Retinal fundus photograph — 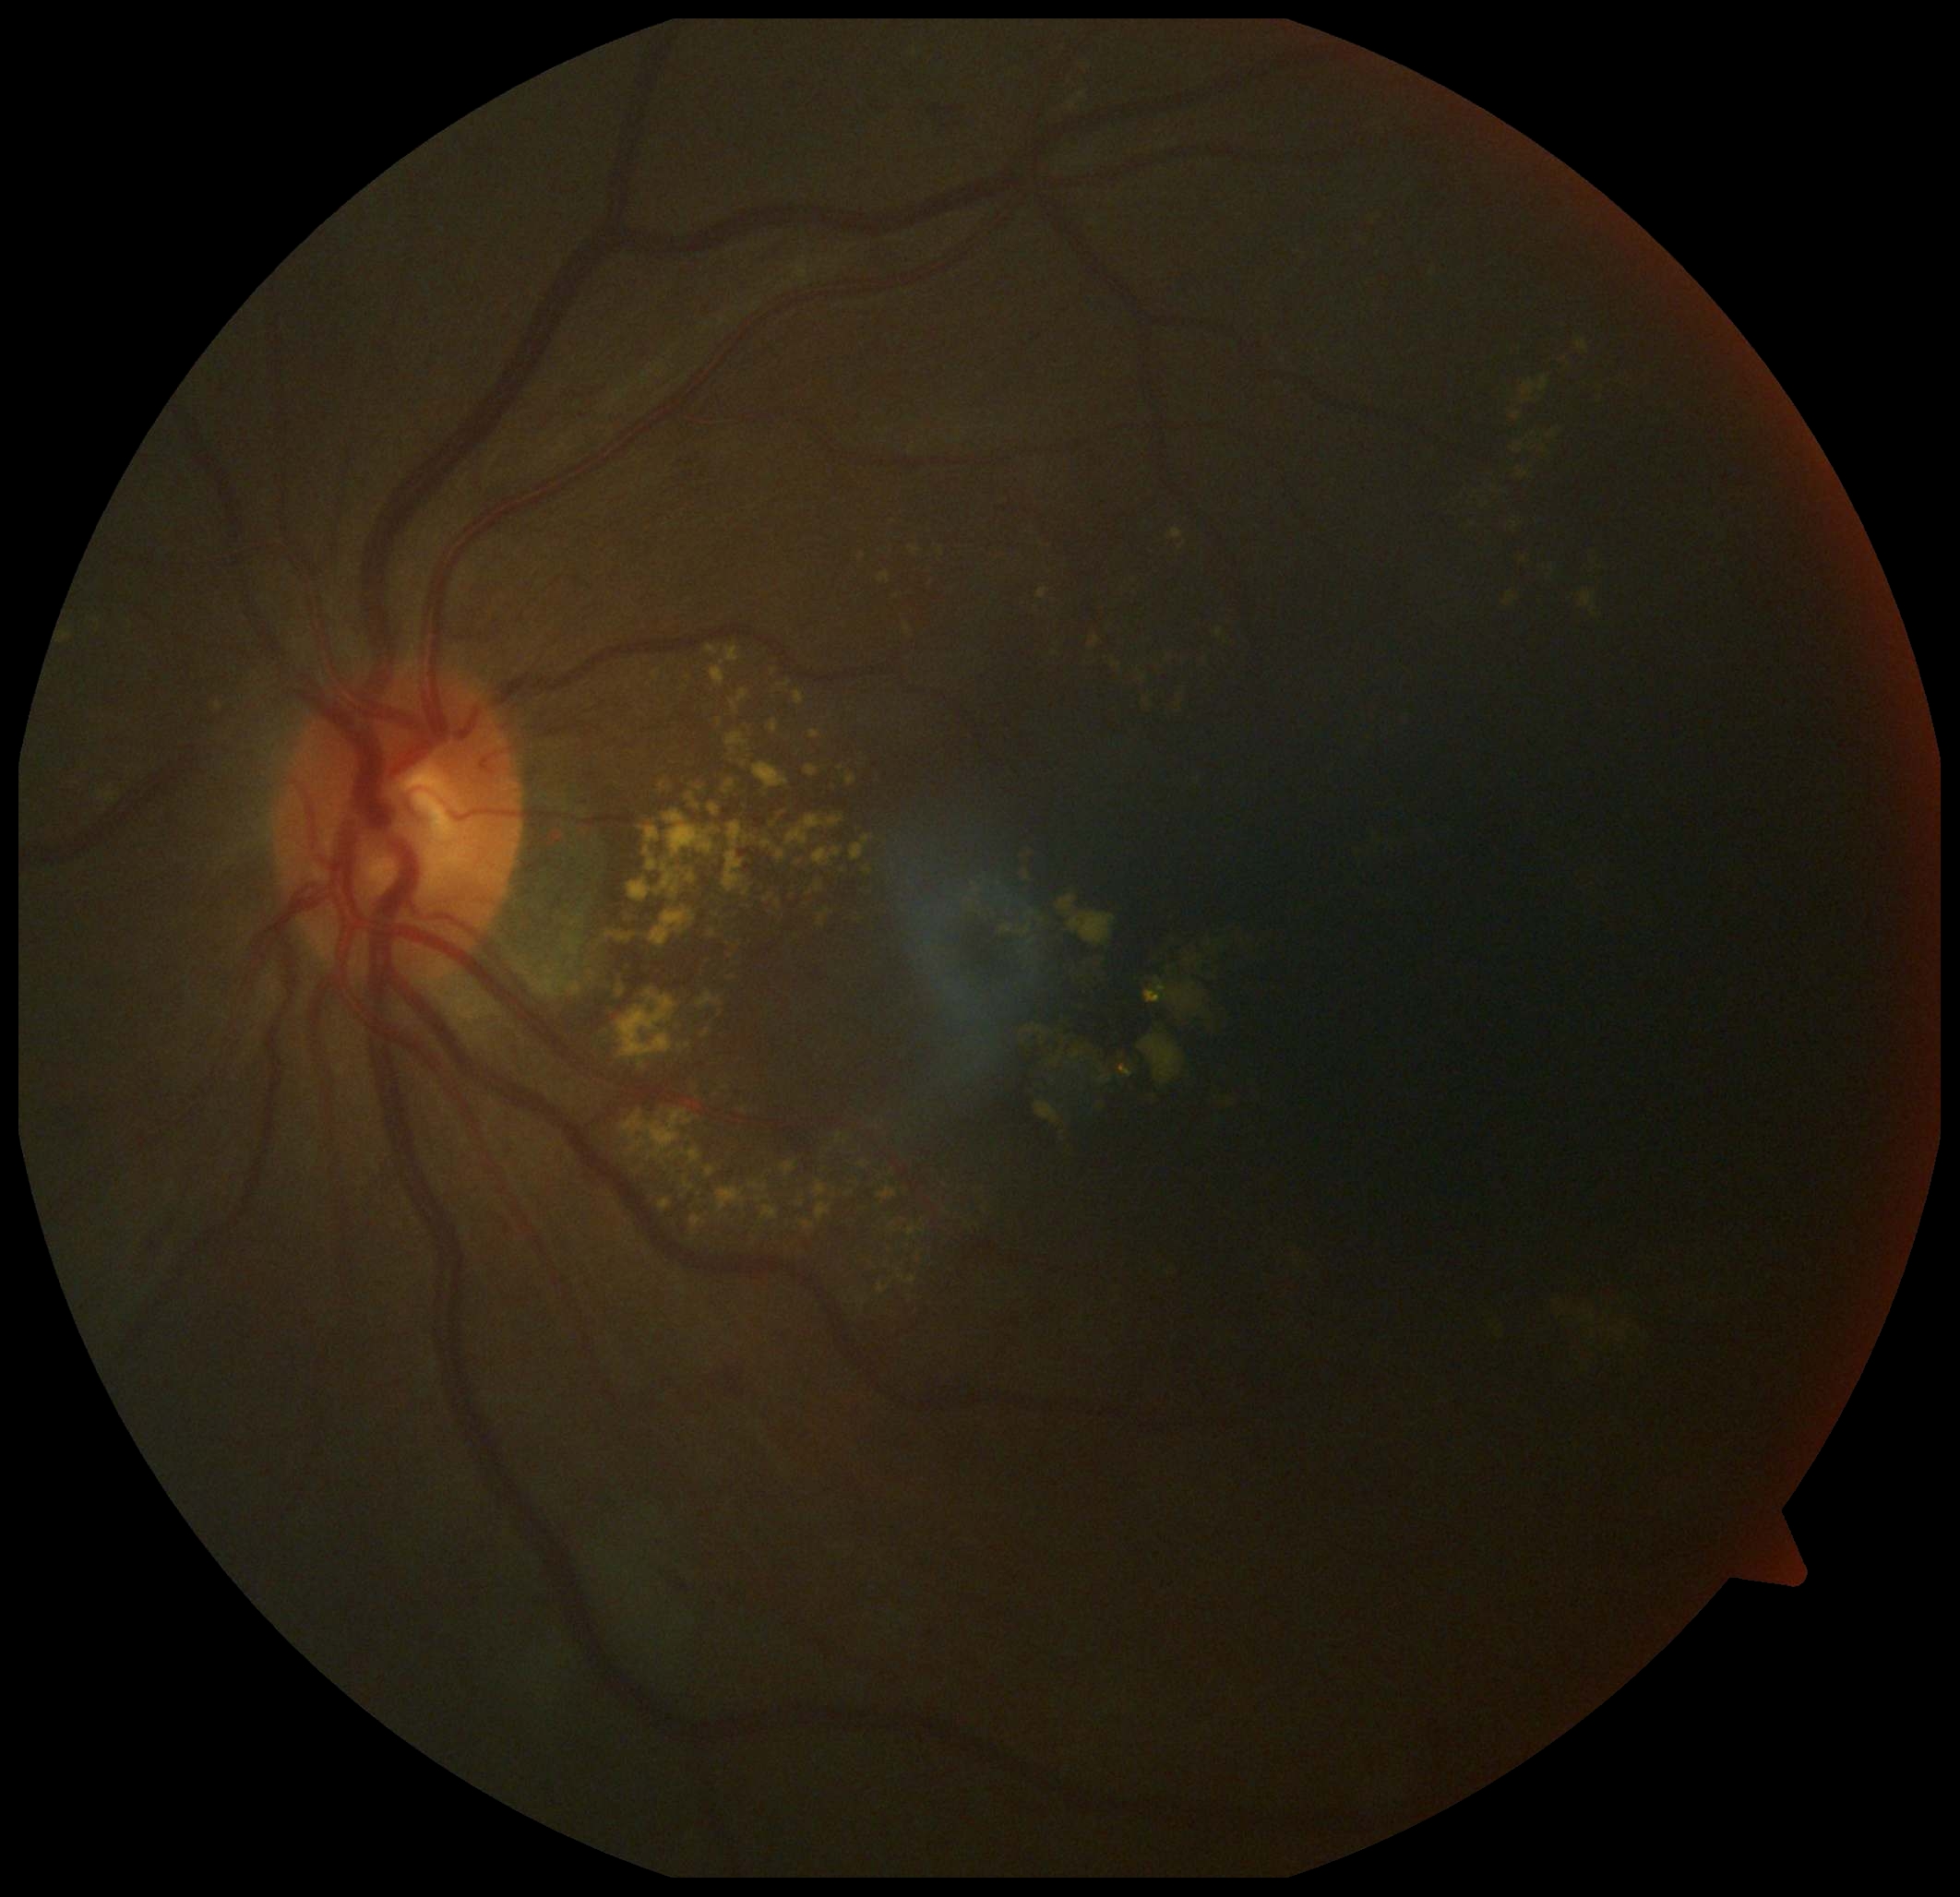 Diabetic retinopathy: moderate non-proliferative diabetic retinopathy (grade 2).